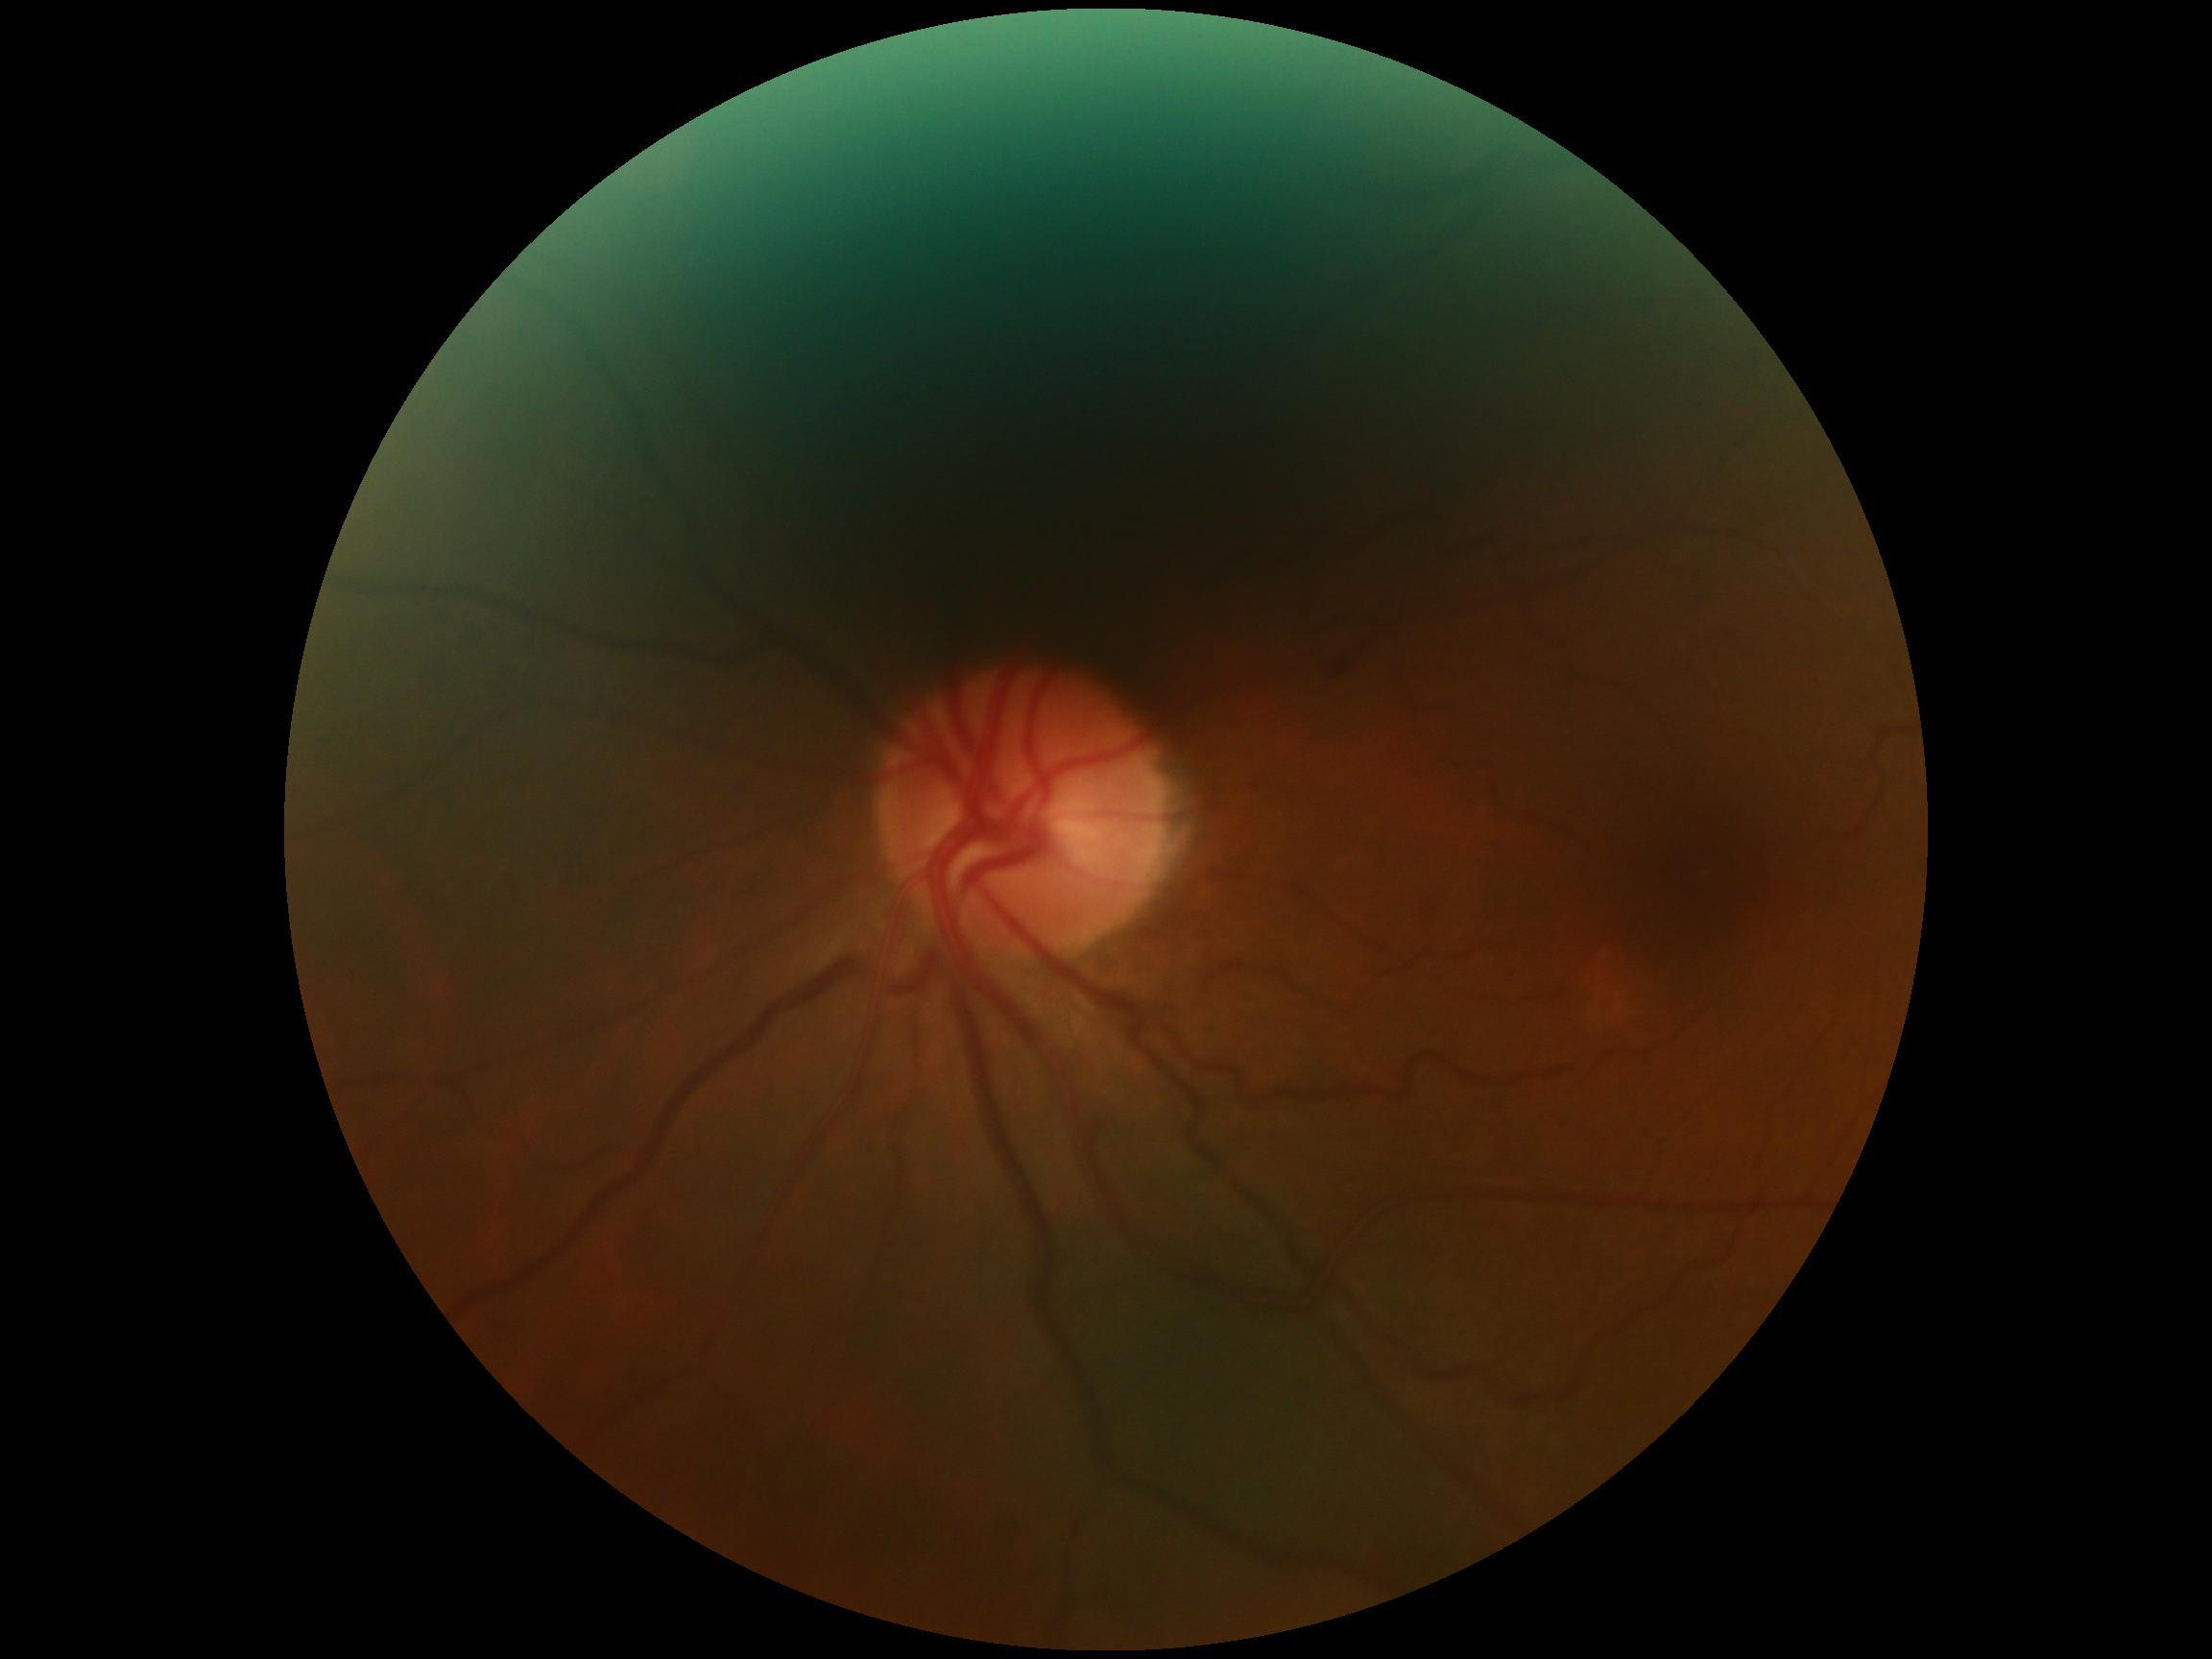
Diabetic retinopathy (DR): 2.
DR class: non-proliferative diabetic retinopathy.